2352x1568 · CFP:
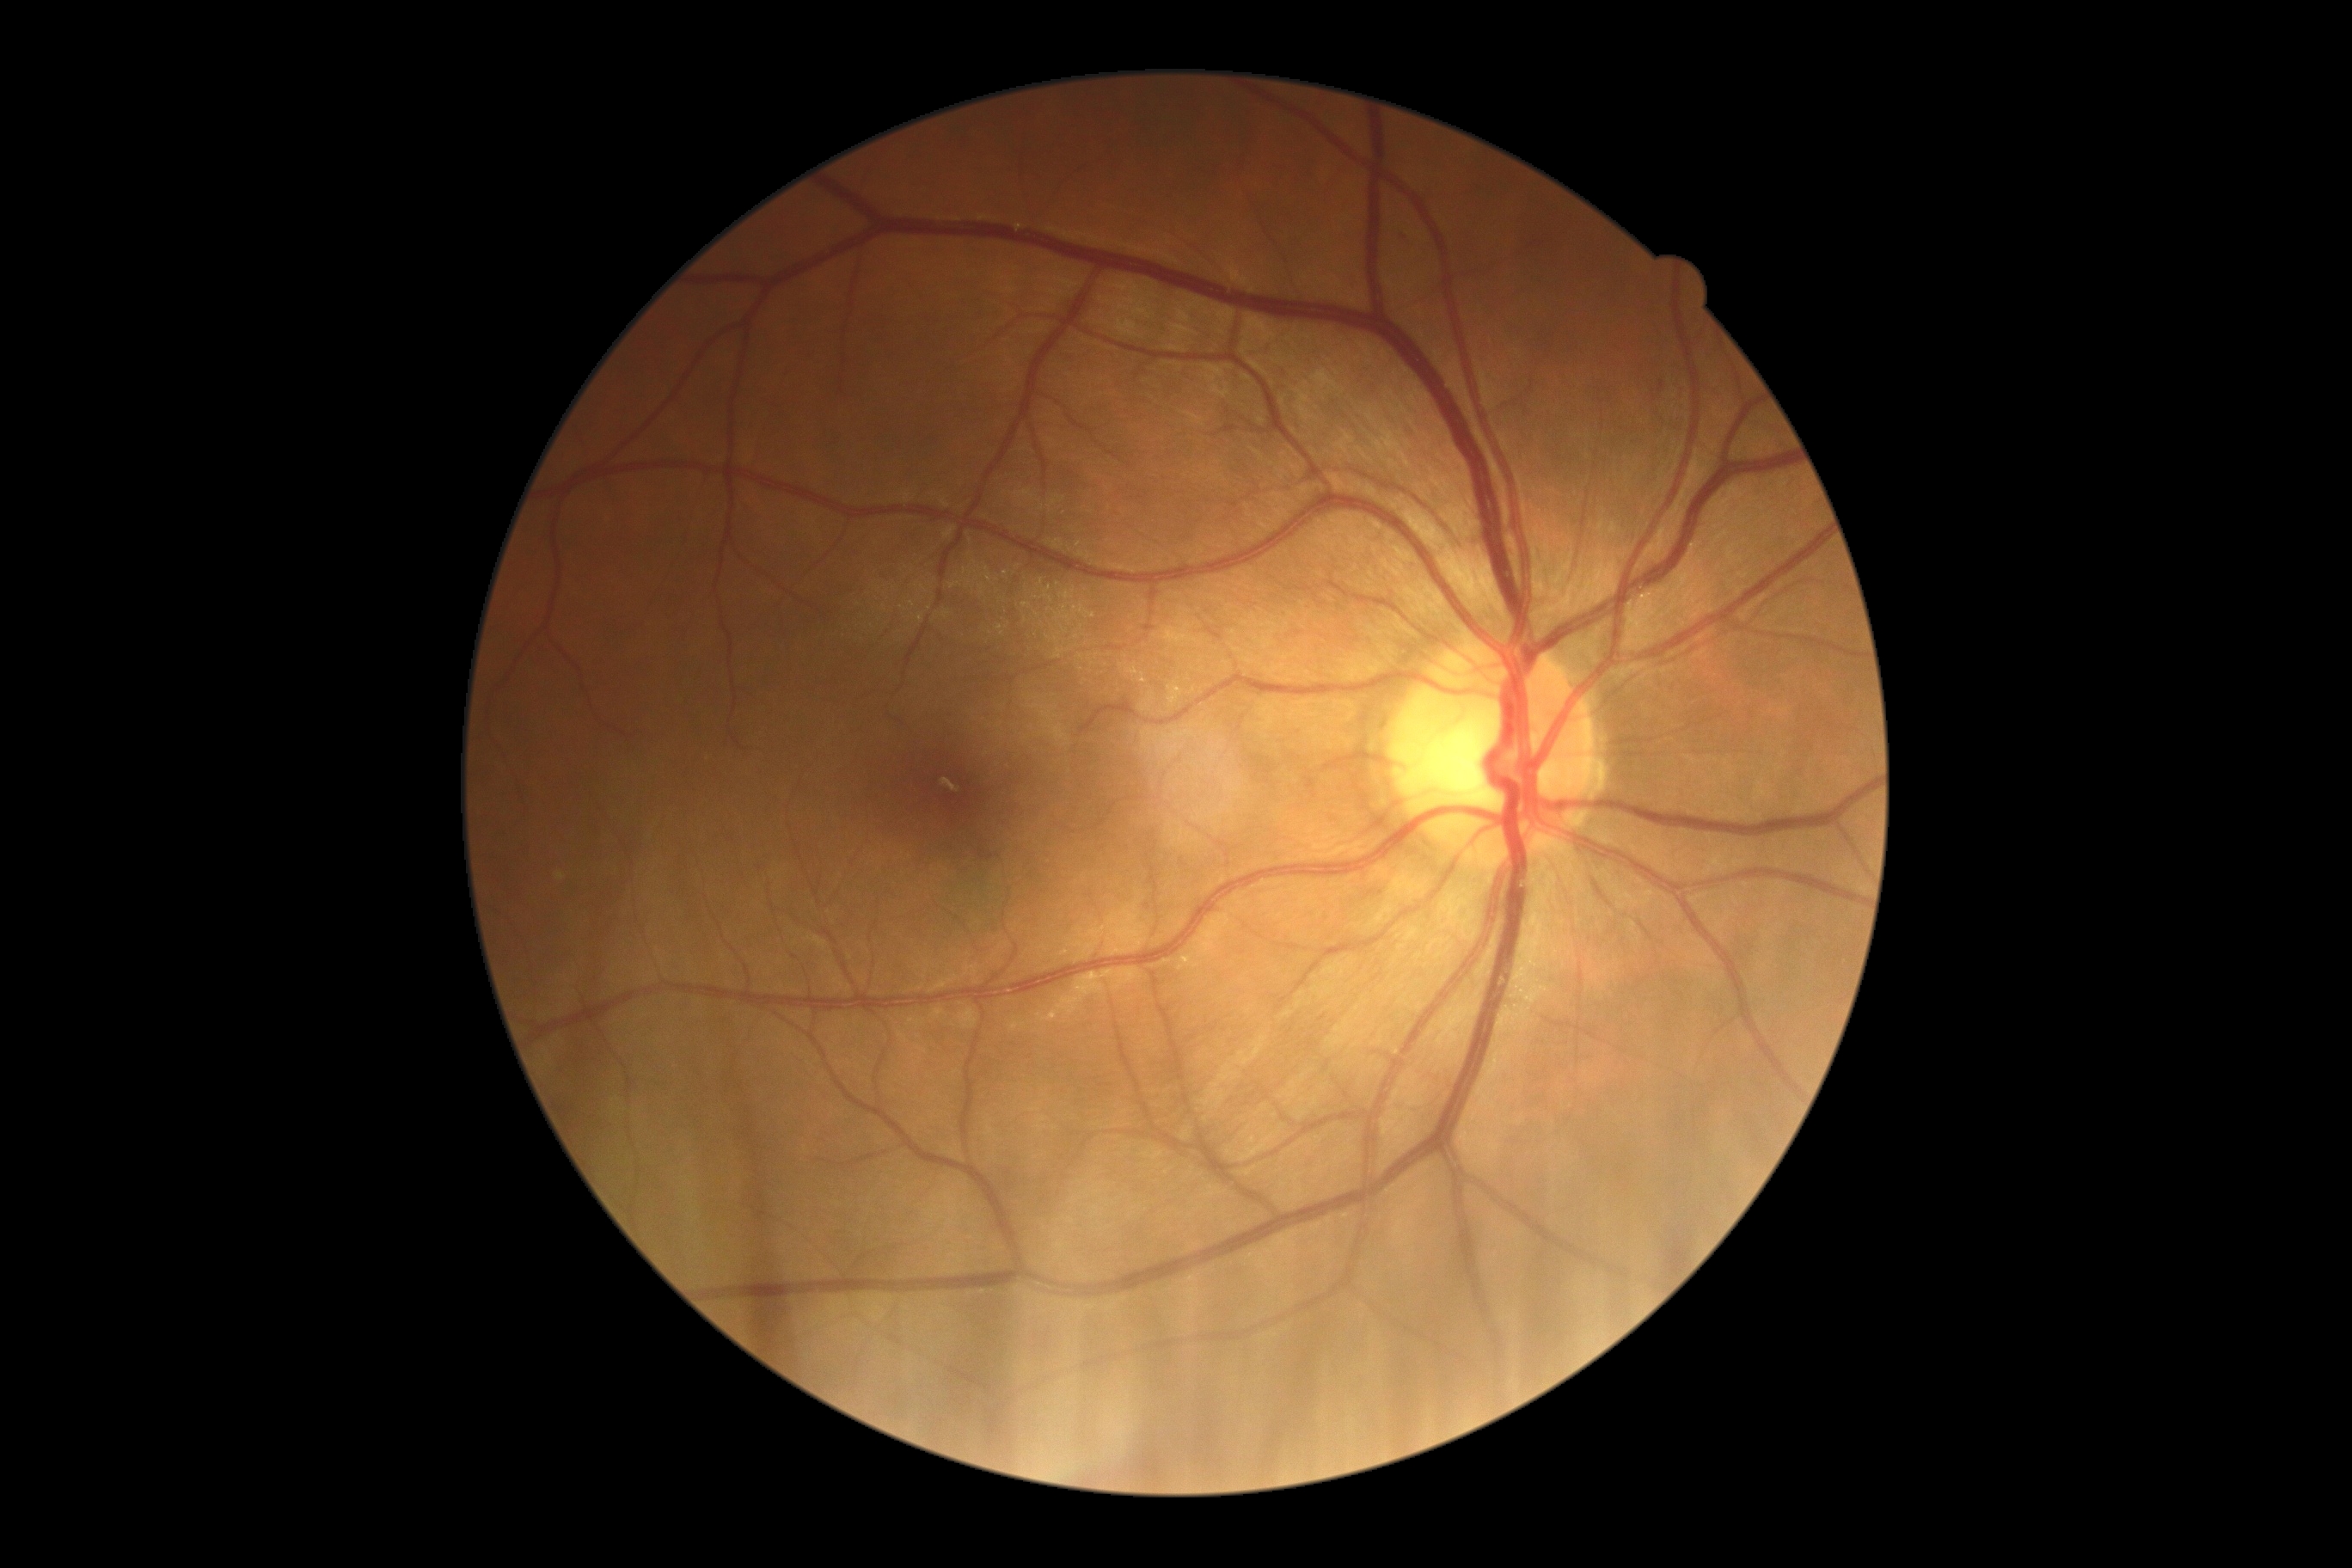 diabetic retinopathy grade@0, DR impression@negative for DR.